NIDEK AFC-230 fundus camera.
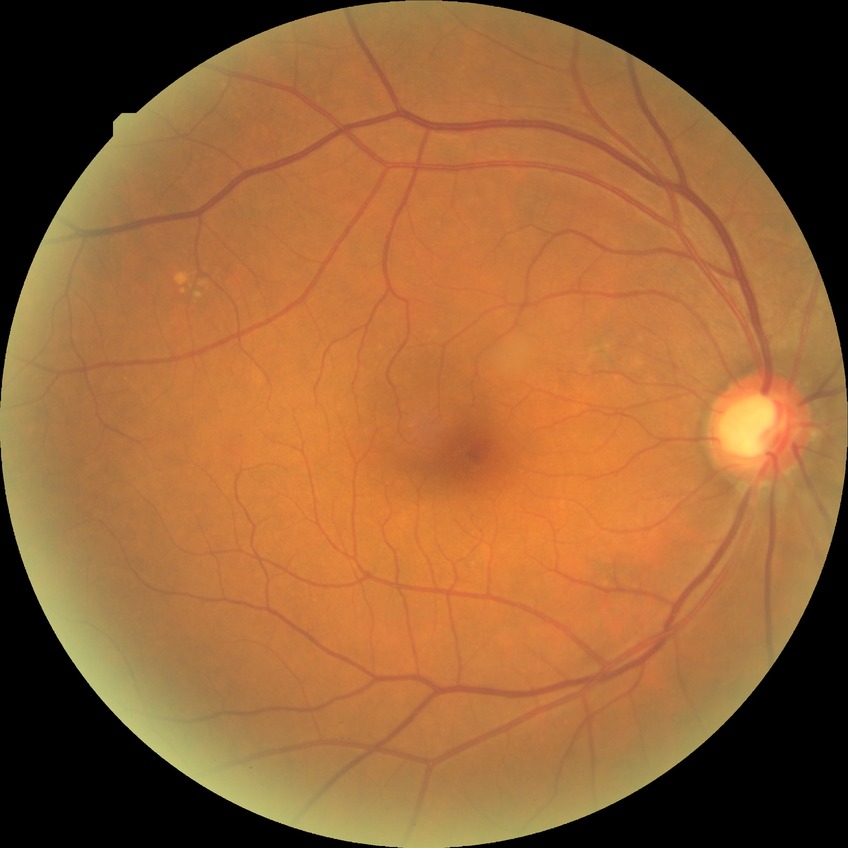
Davis grading: no diabetic retinopathy.